CFP
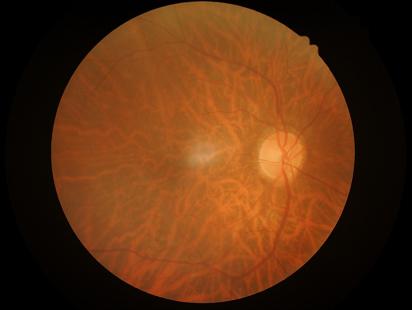
Good dynamic range. Image is sharp throughout the field. No over- or under-exposure. Overall quality is good and the image is gradable.